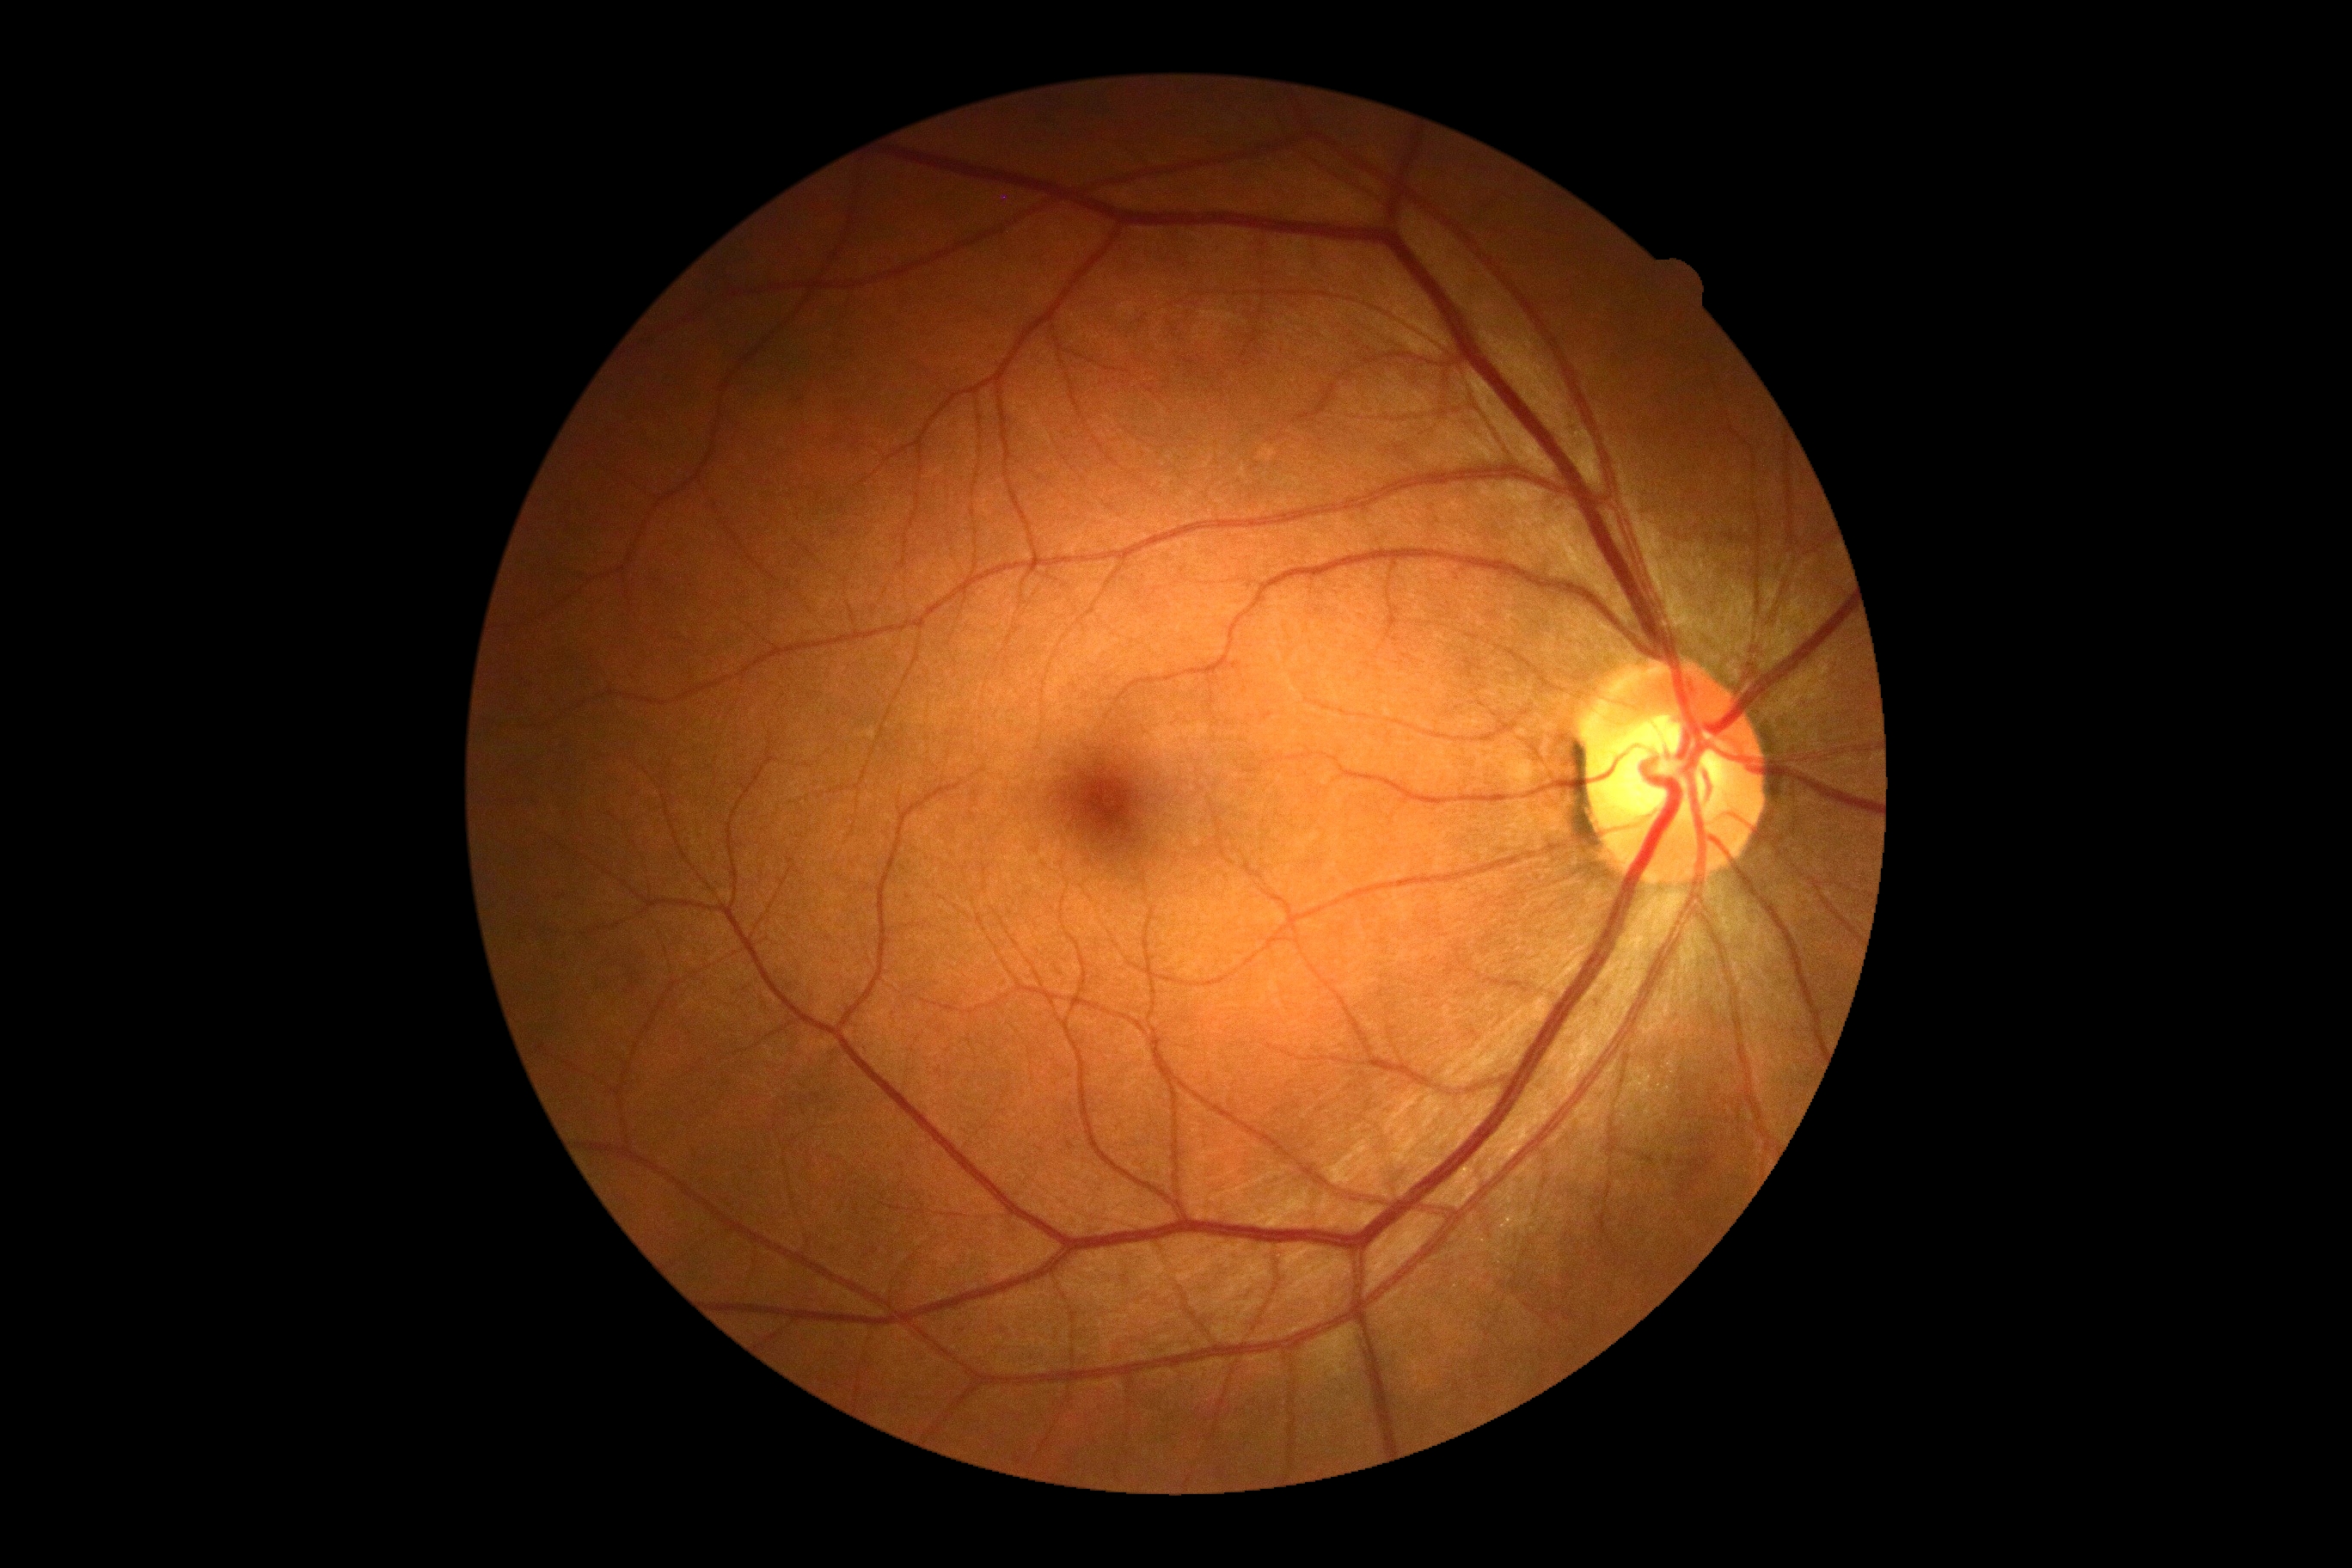
{
  "dr_grade": "no apparent retinopathy (grade 0) — no visible signs of diabetic retinopathy"
}